Image size 512x512
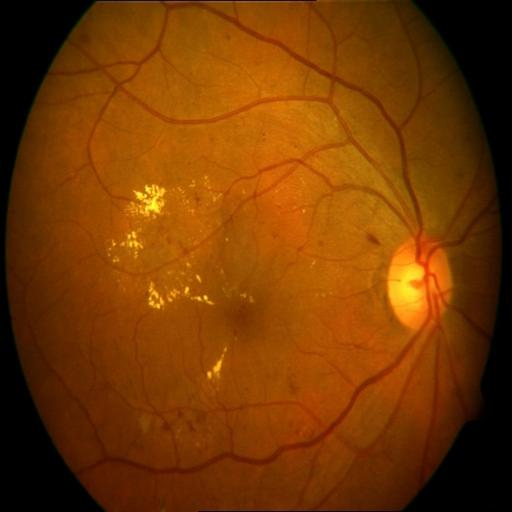
Demonstrates exudation.